Retinal fundus photograph. Image size 2048x1536.
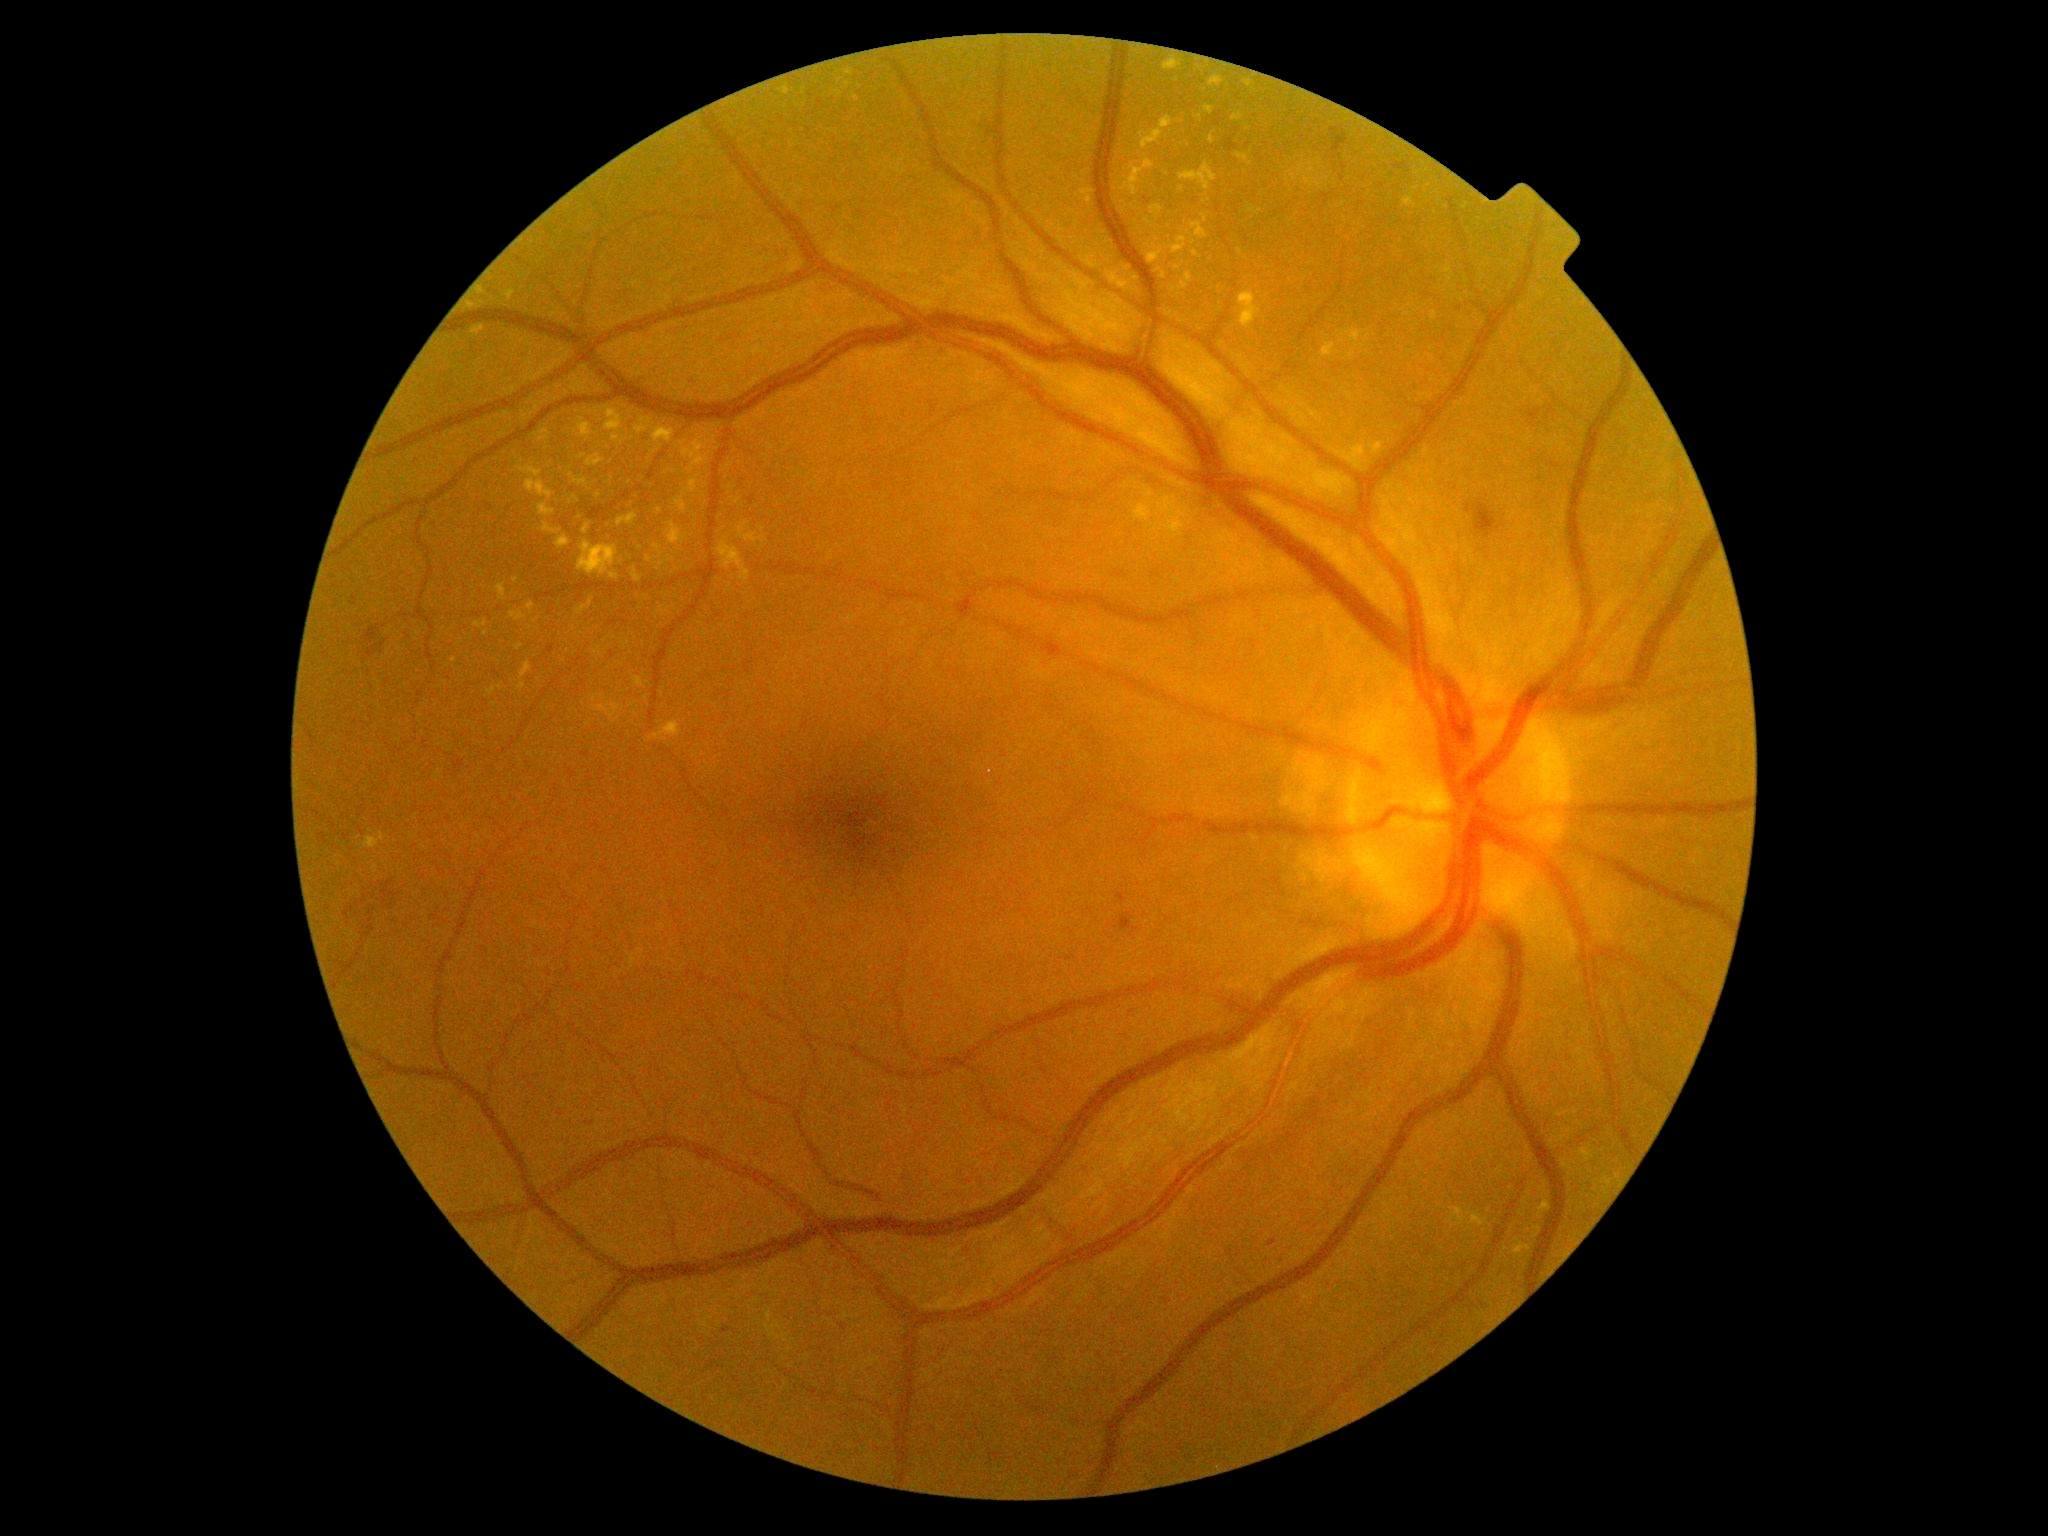

Diabetic retinopathy (DR): 2
Selected lesions:
hard exudates (EXs) (continued): x1=582, y1=524, x2=591, y2=535; x1=845, y1=69, x2=853, y2=76; x1=1175, y1=265, x2=1183, y2=271; x1=650, y1=722, x2=683, y2=742; x1=1209, y1=132, x2=1215, y2=145; x1=535, y1=426, x2=551, y2=442; x1=632, y1=677, x2=644, y2=689; x1=1342, y1=328, x2=1363, y2=347; x1=576, y1=598, x2=595, y2=615; x1=1179, y1=162, x2=1218, y2=191; x1=496, y1=584, x2=508, y2=601; x1=592, y1=694, x2=605, y2=703
Additional small EXs near point(494, 704); point(487, 634); point(1127, 269); point(1294, 178); point(564, 661); point(1319, 186); point(840, 81)